Fundus image cropped to the optic disc:
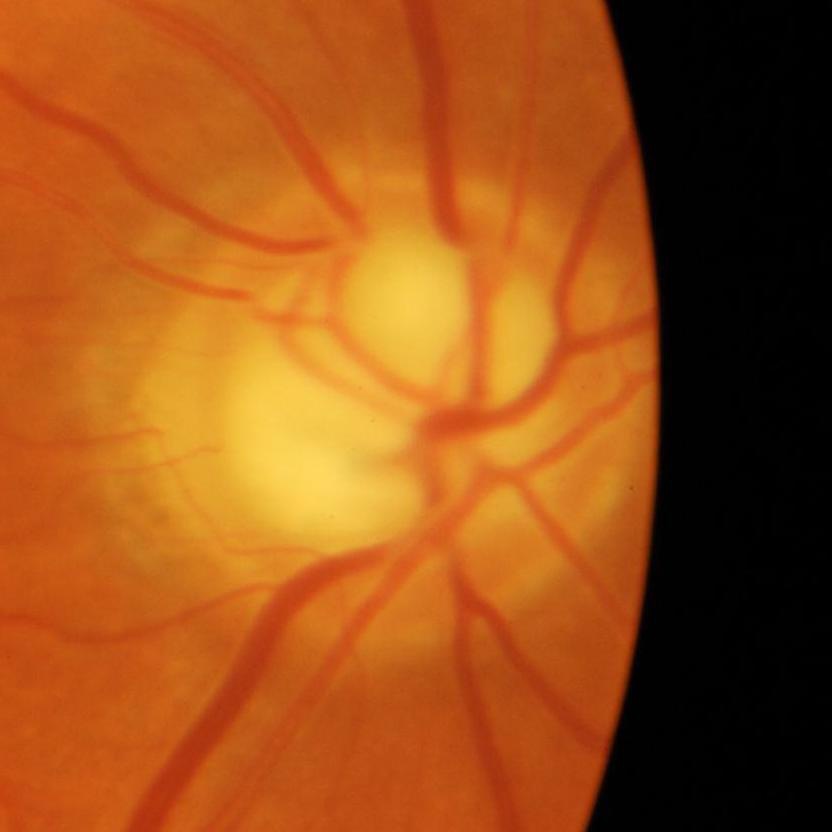 Finding = glaucomatous findings.